2352 by 1568 pixels; CFP:
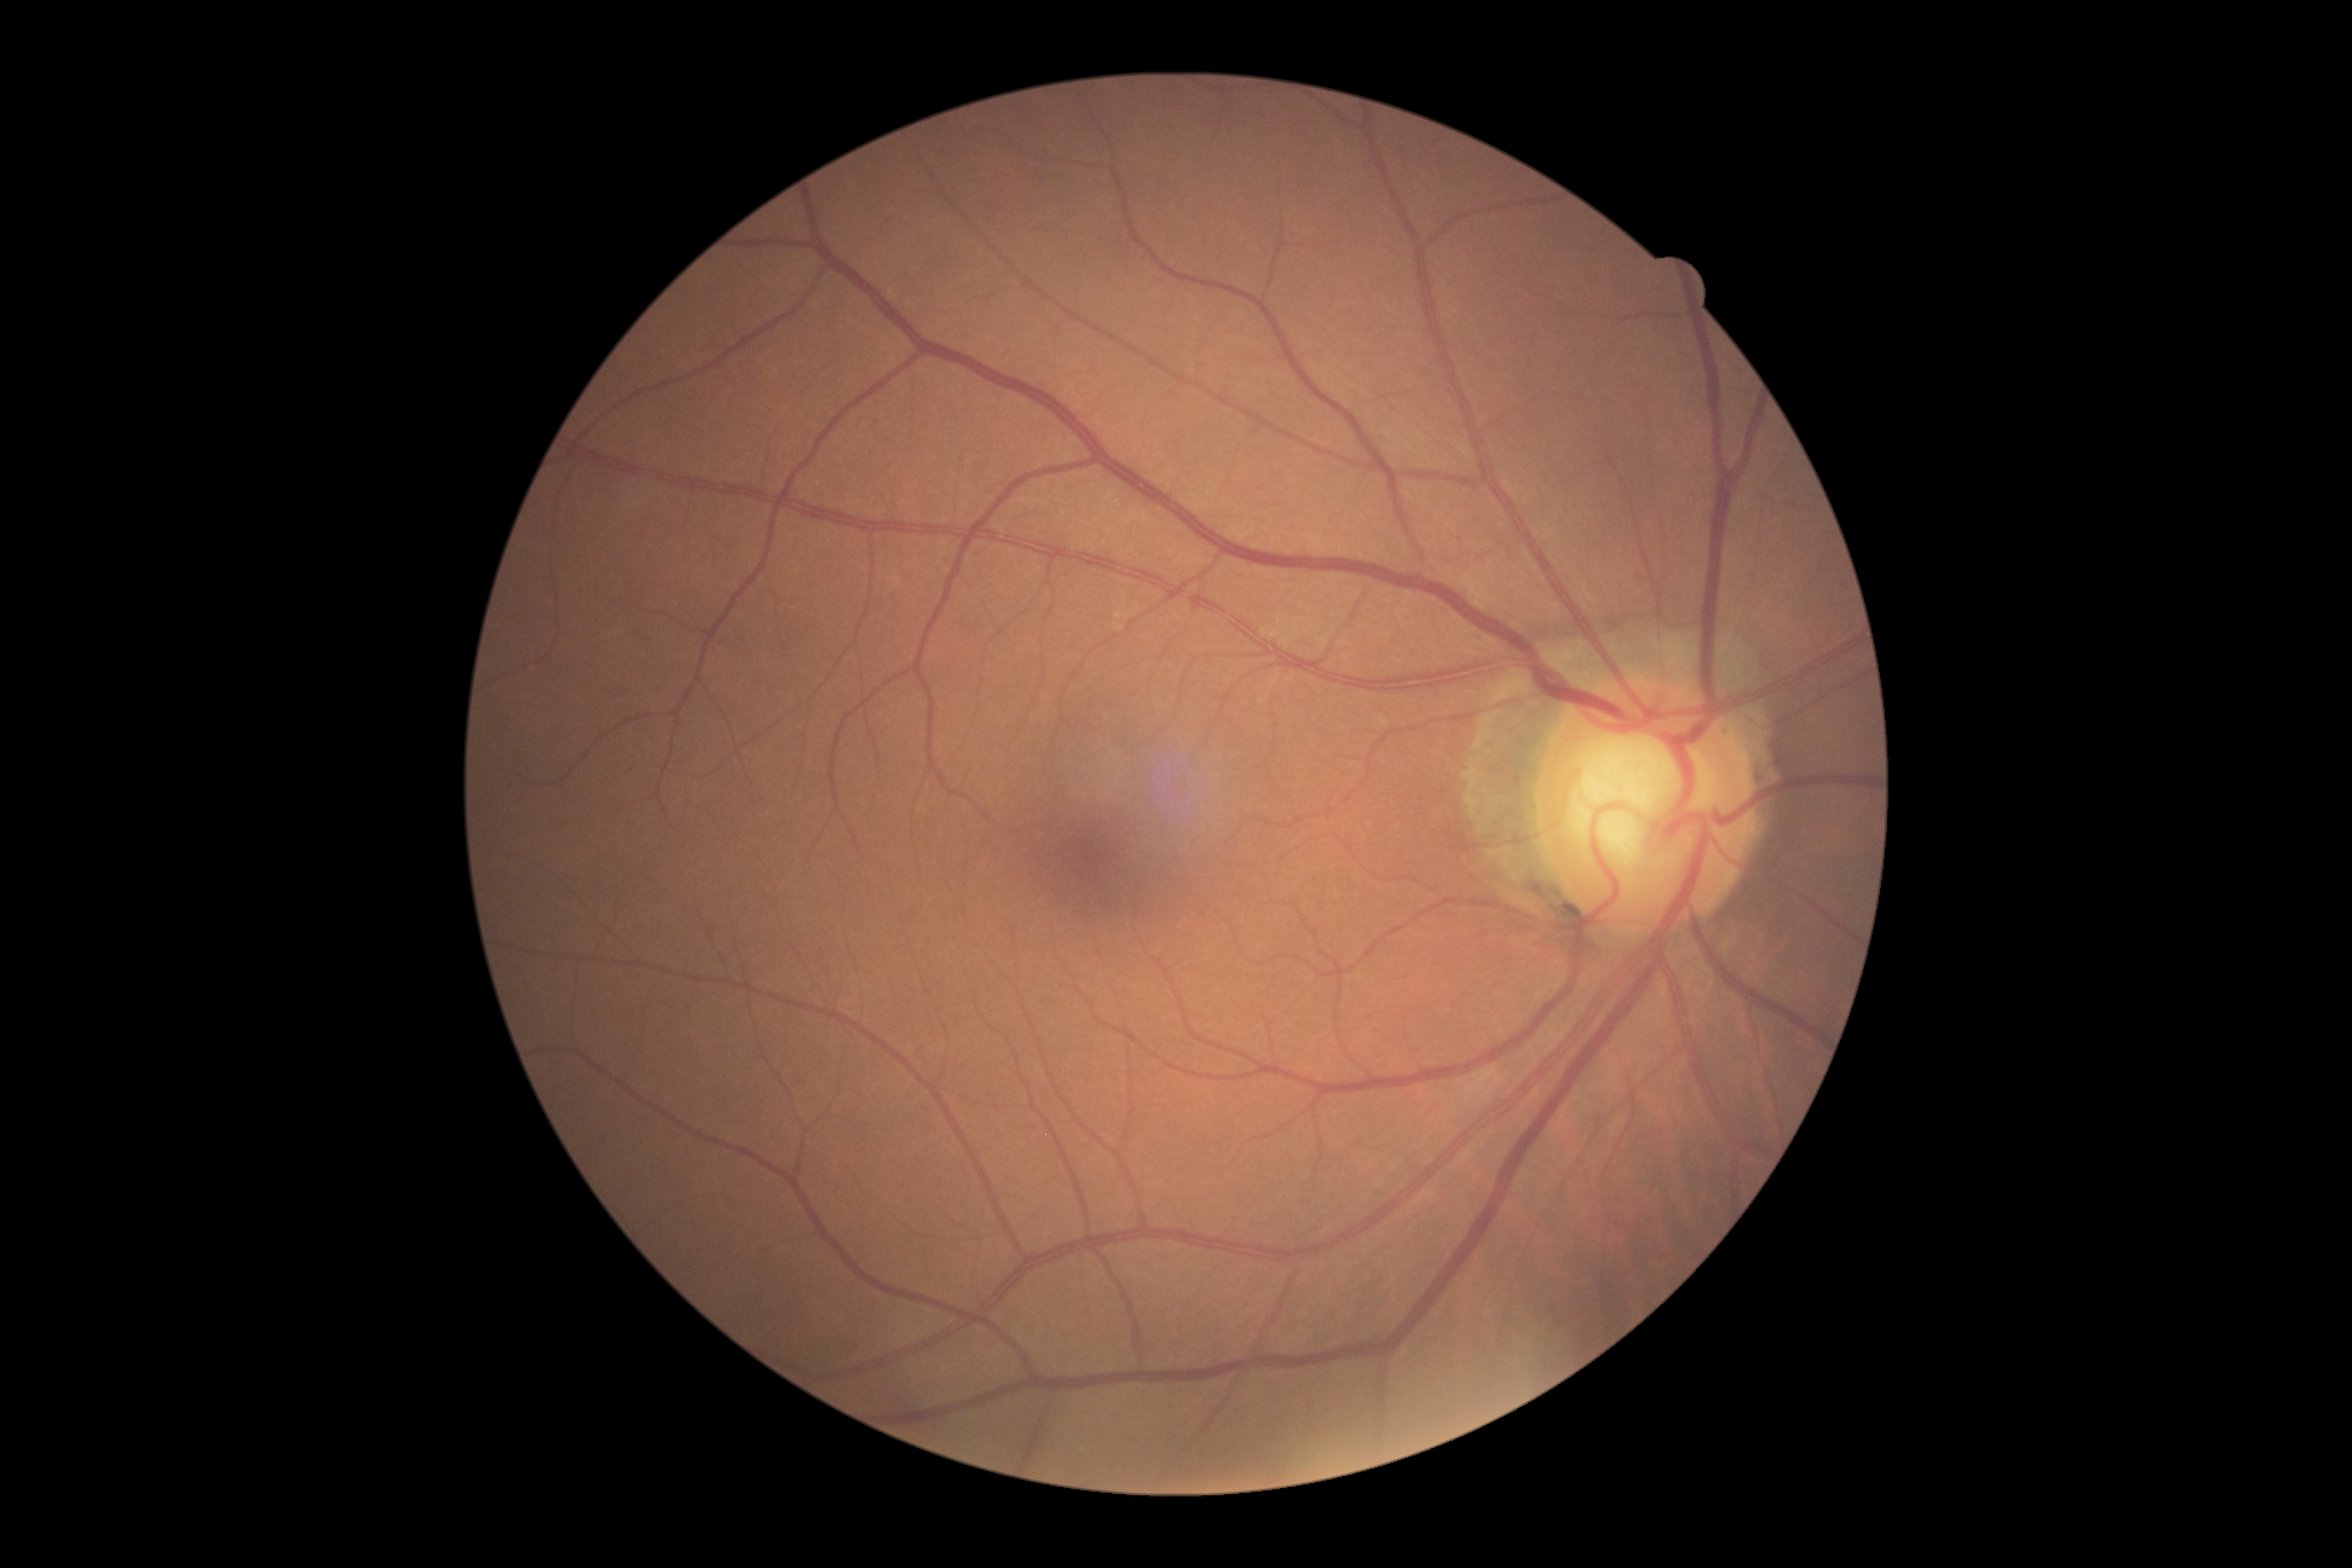
Diabetic retinopathy (DR): no apparent diabetic retinopathy (grade 0) — no visible signs of diabetic retinopathy.